Ultra-widefield (UWF) fundus image · FOV: 200 degrees:
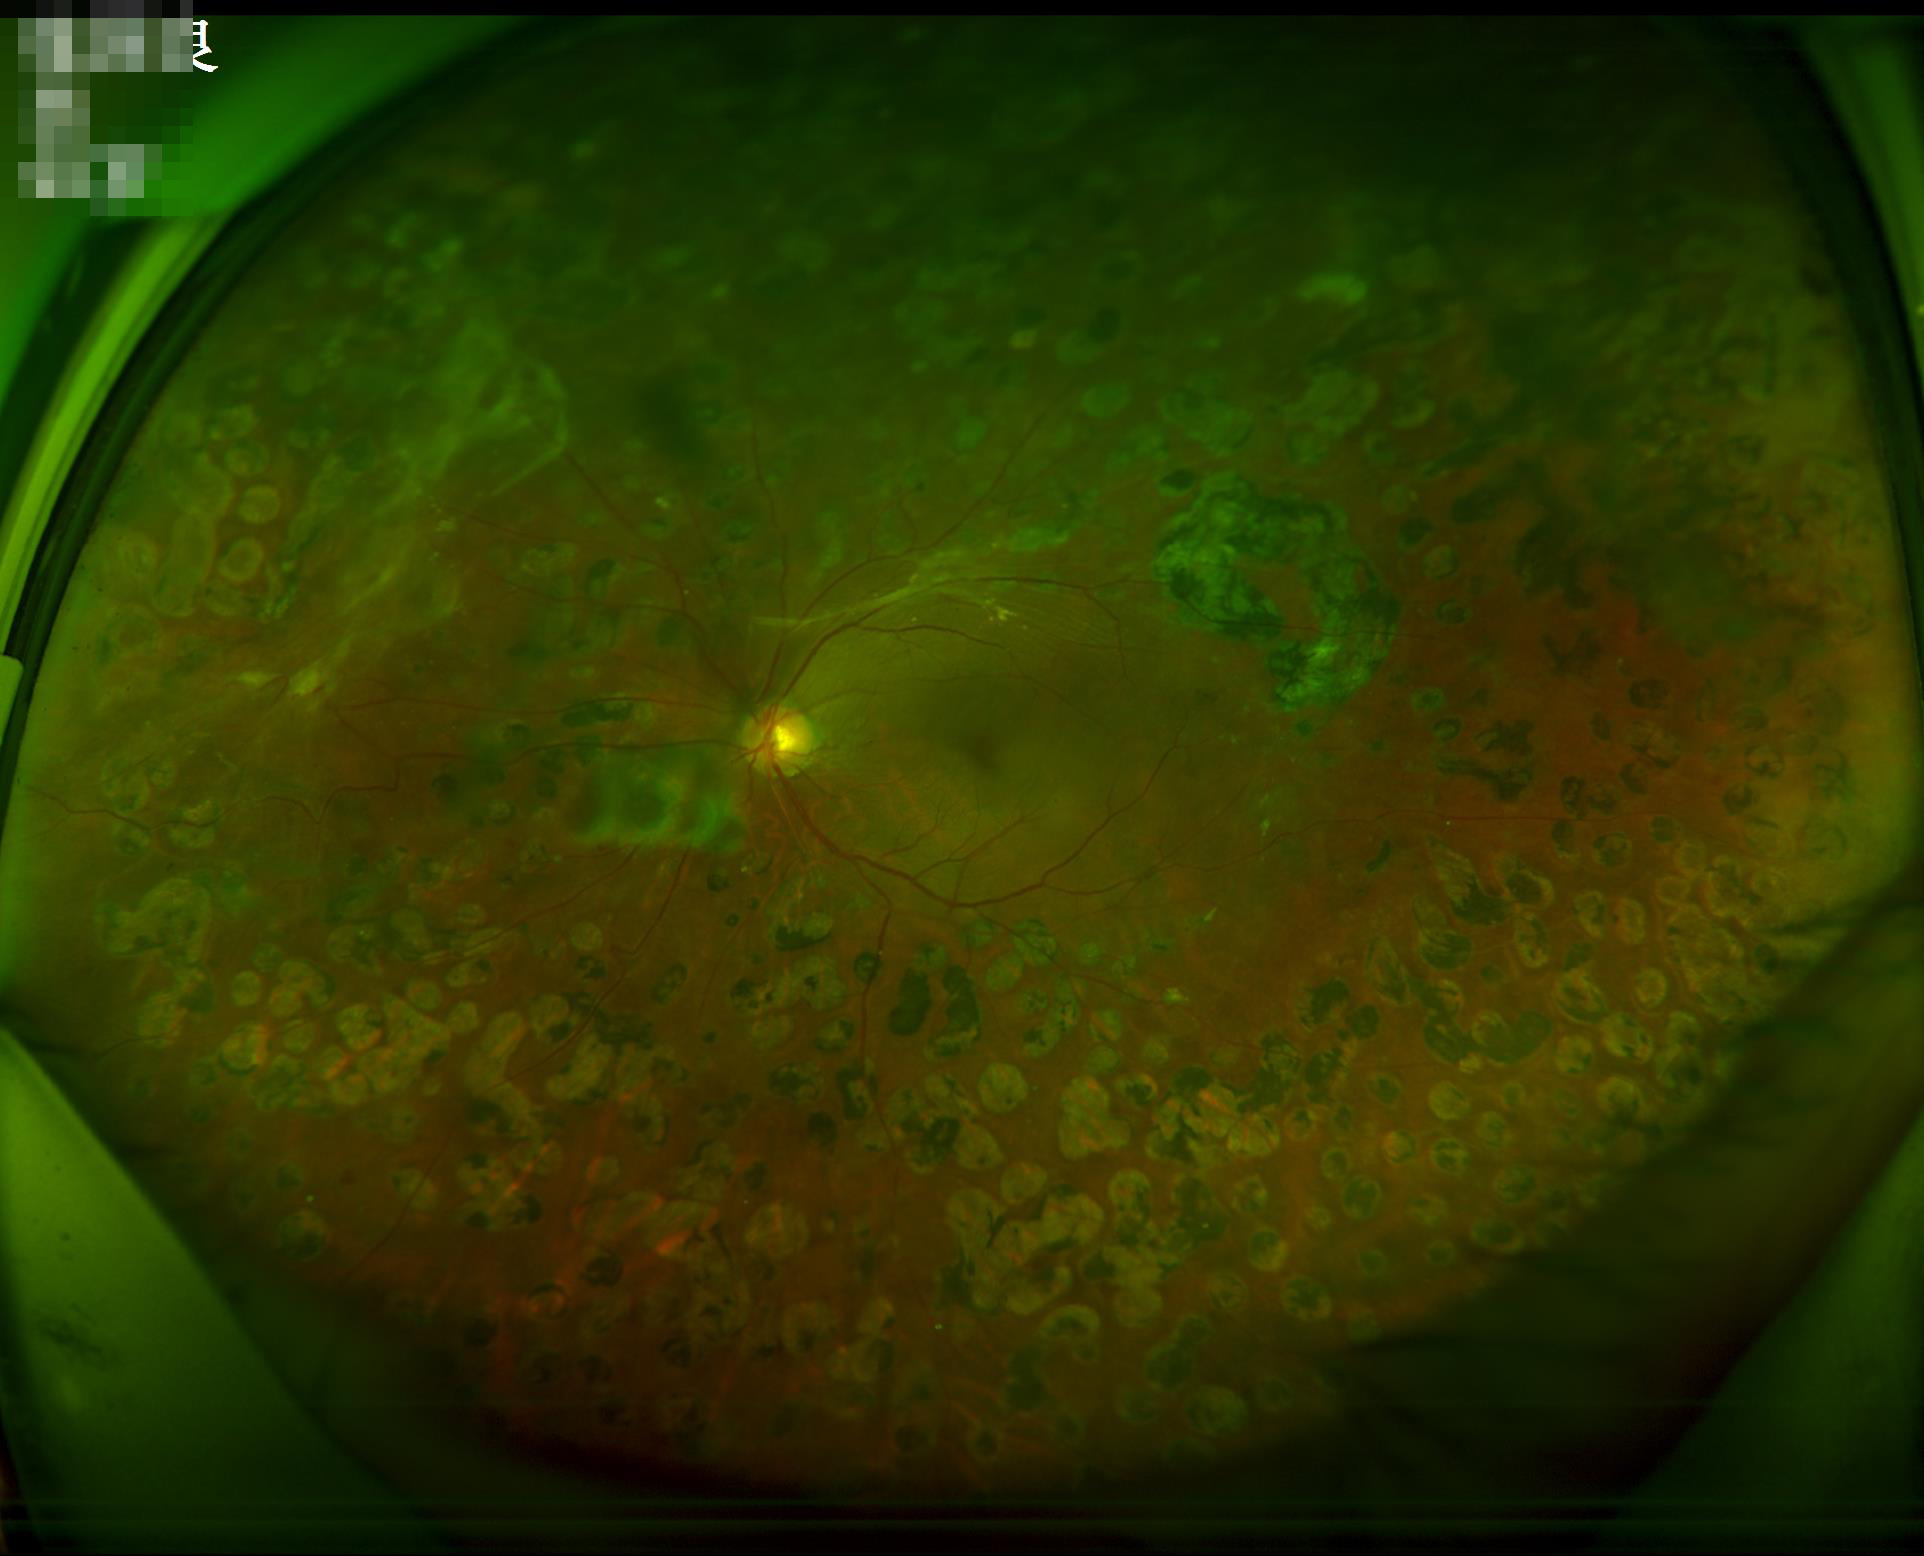

Quality assessment: overall: satisfactory | sharpness: clear | contrast: good.